Without pupil dilation · graded on the modified Davis scale
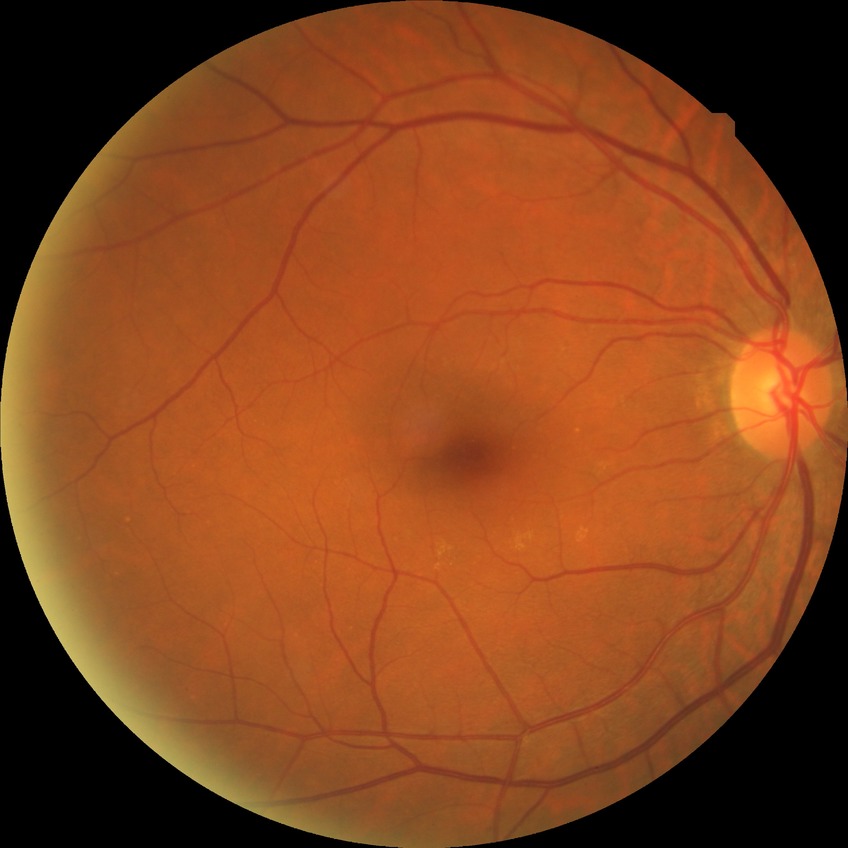
modified Davis classification = no diabetic retinopathy